Color fundus photograph, 45° field of view, acquired with a NIDEK AFC-230, 848x848 — 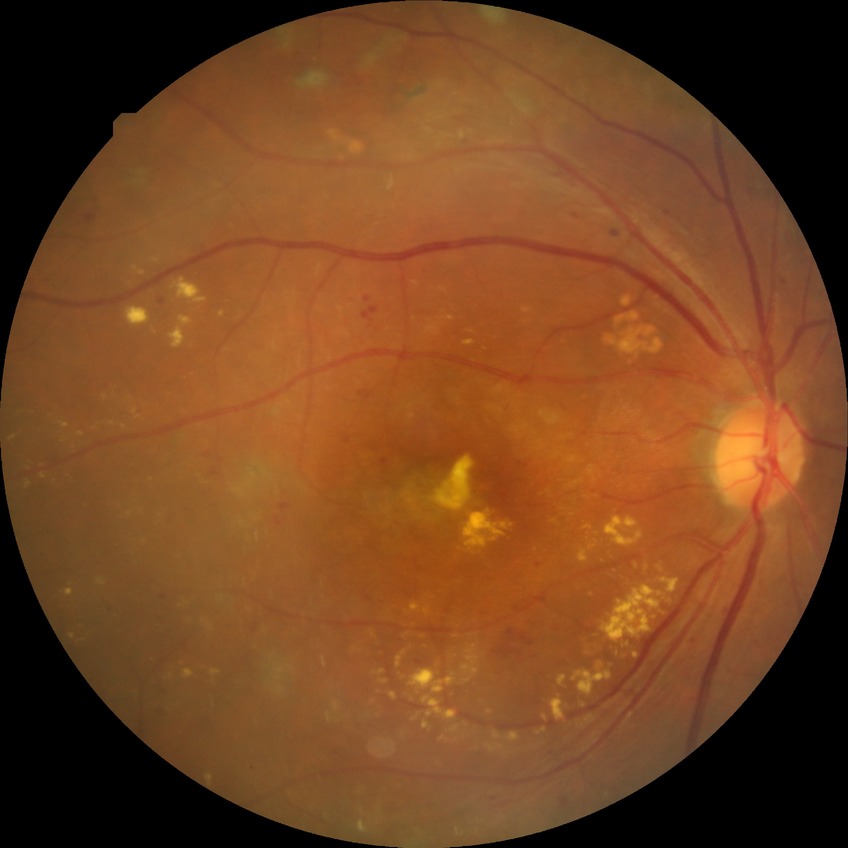

DR: PDR.